45° field of view · no pharmacologic dilation:
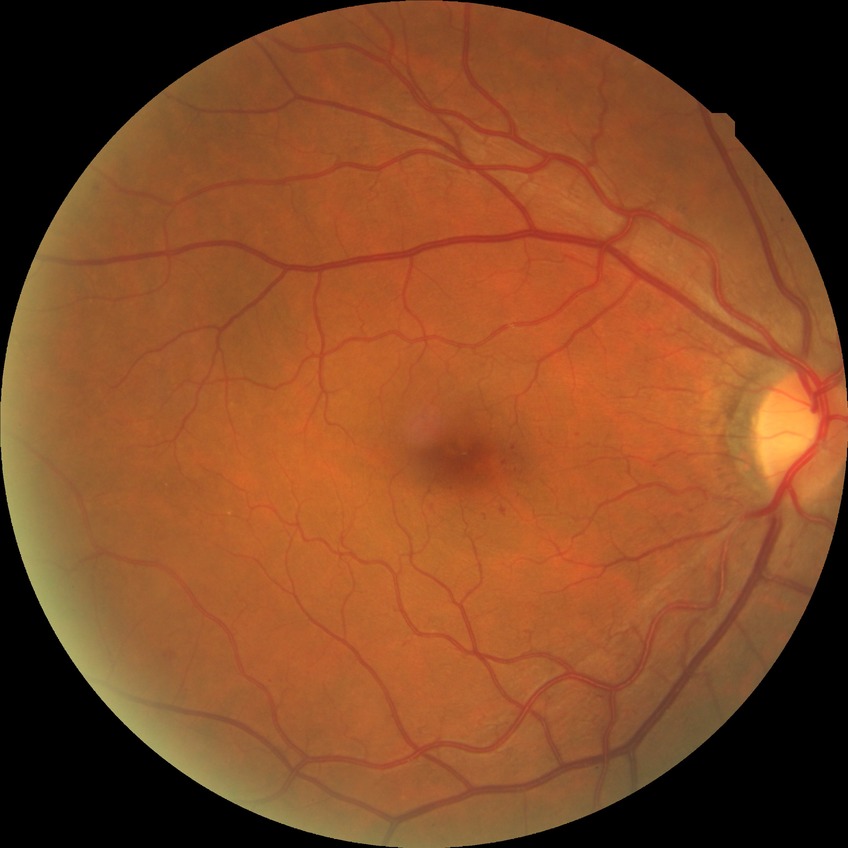
modified Davis grading: simple diabetic retinopathy.